45° FOV, retinal fundus photograph.
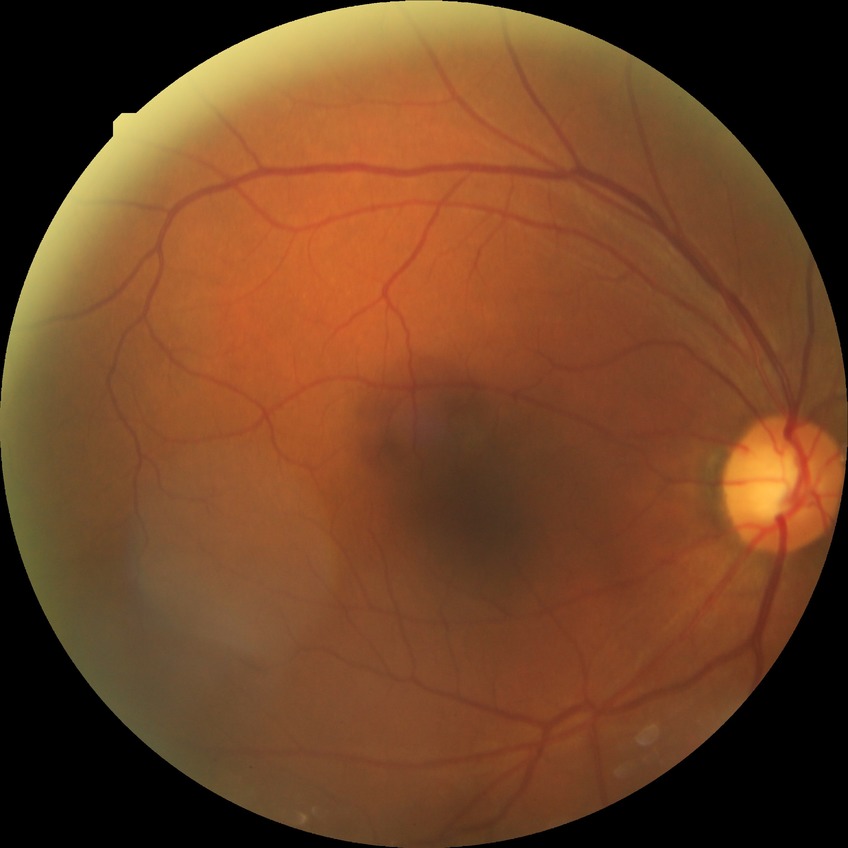

diabetic retinopathy (DR)=no diabetic retinopathy (NDR).